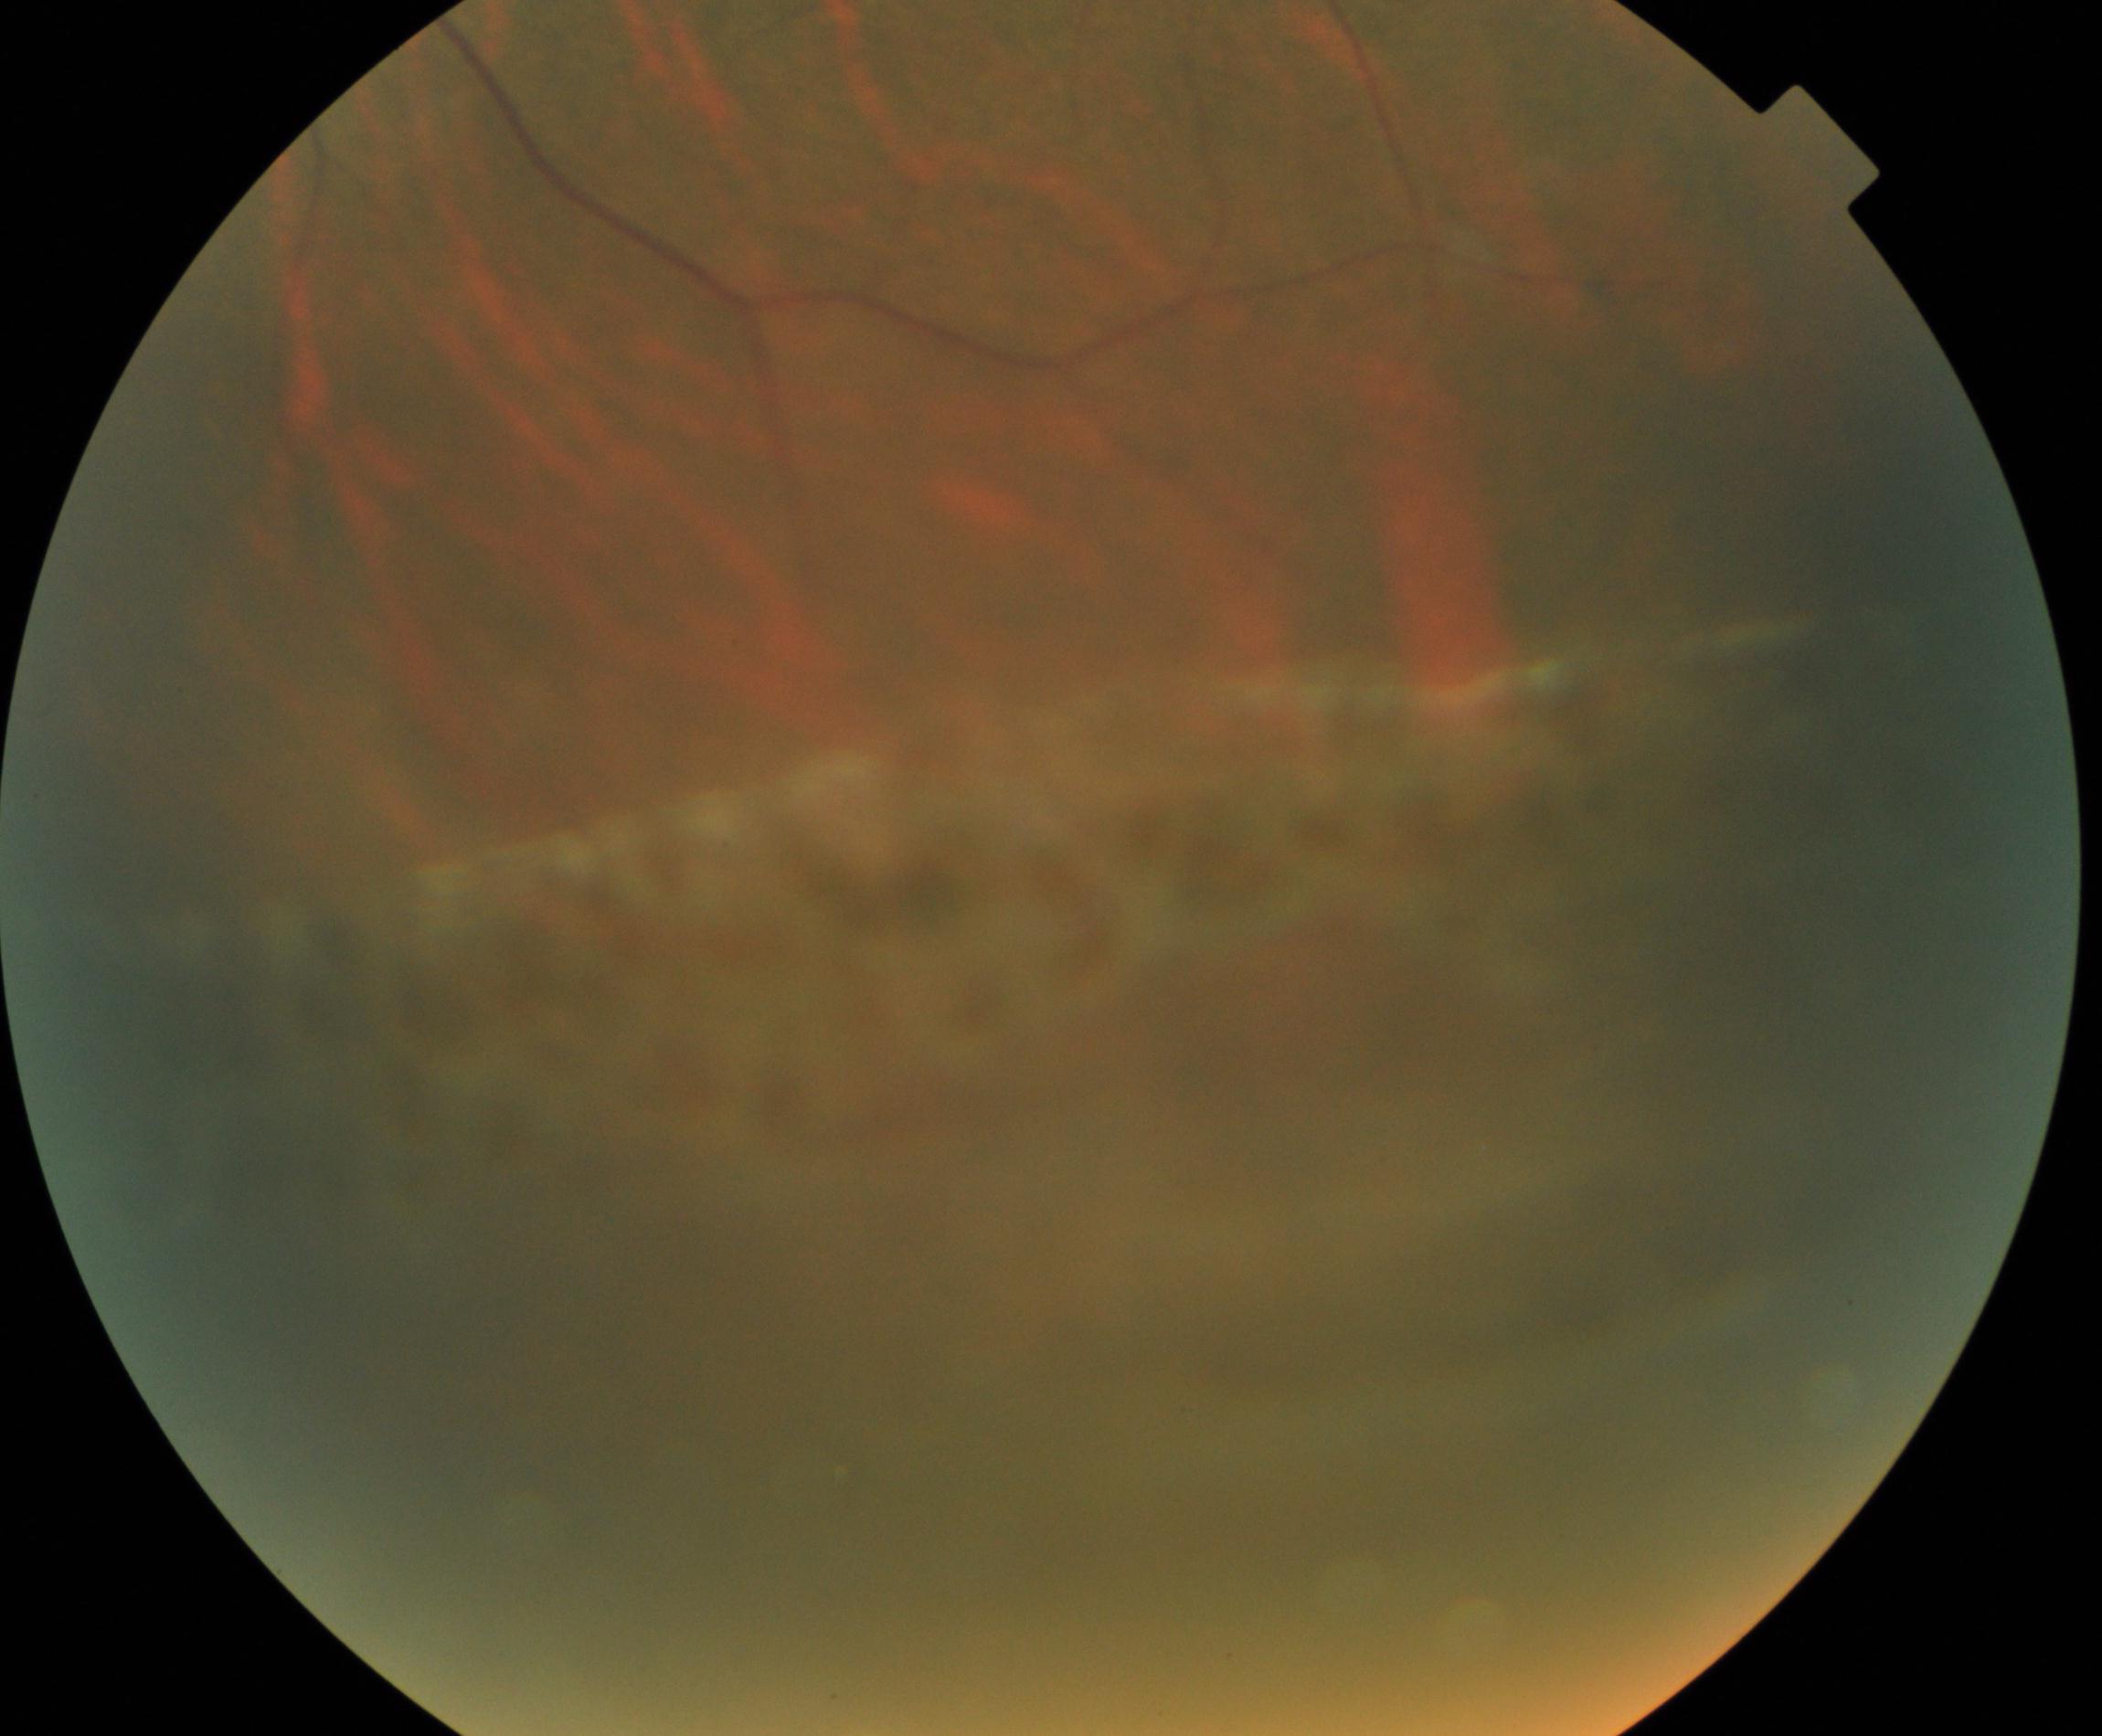

Impression: peripheral retinal degeneration and break. Typically showing lattice, snailtrack, pavingstone, honeycomb, peripheral drusen, microcystoid, or white-without-pressure degeneration, sometimes with a retinal break.